Fundus photo; 50° field of view:
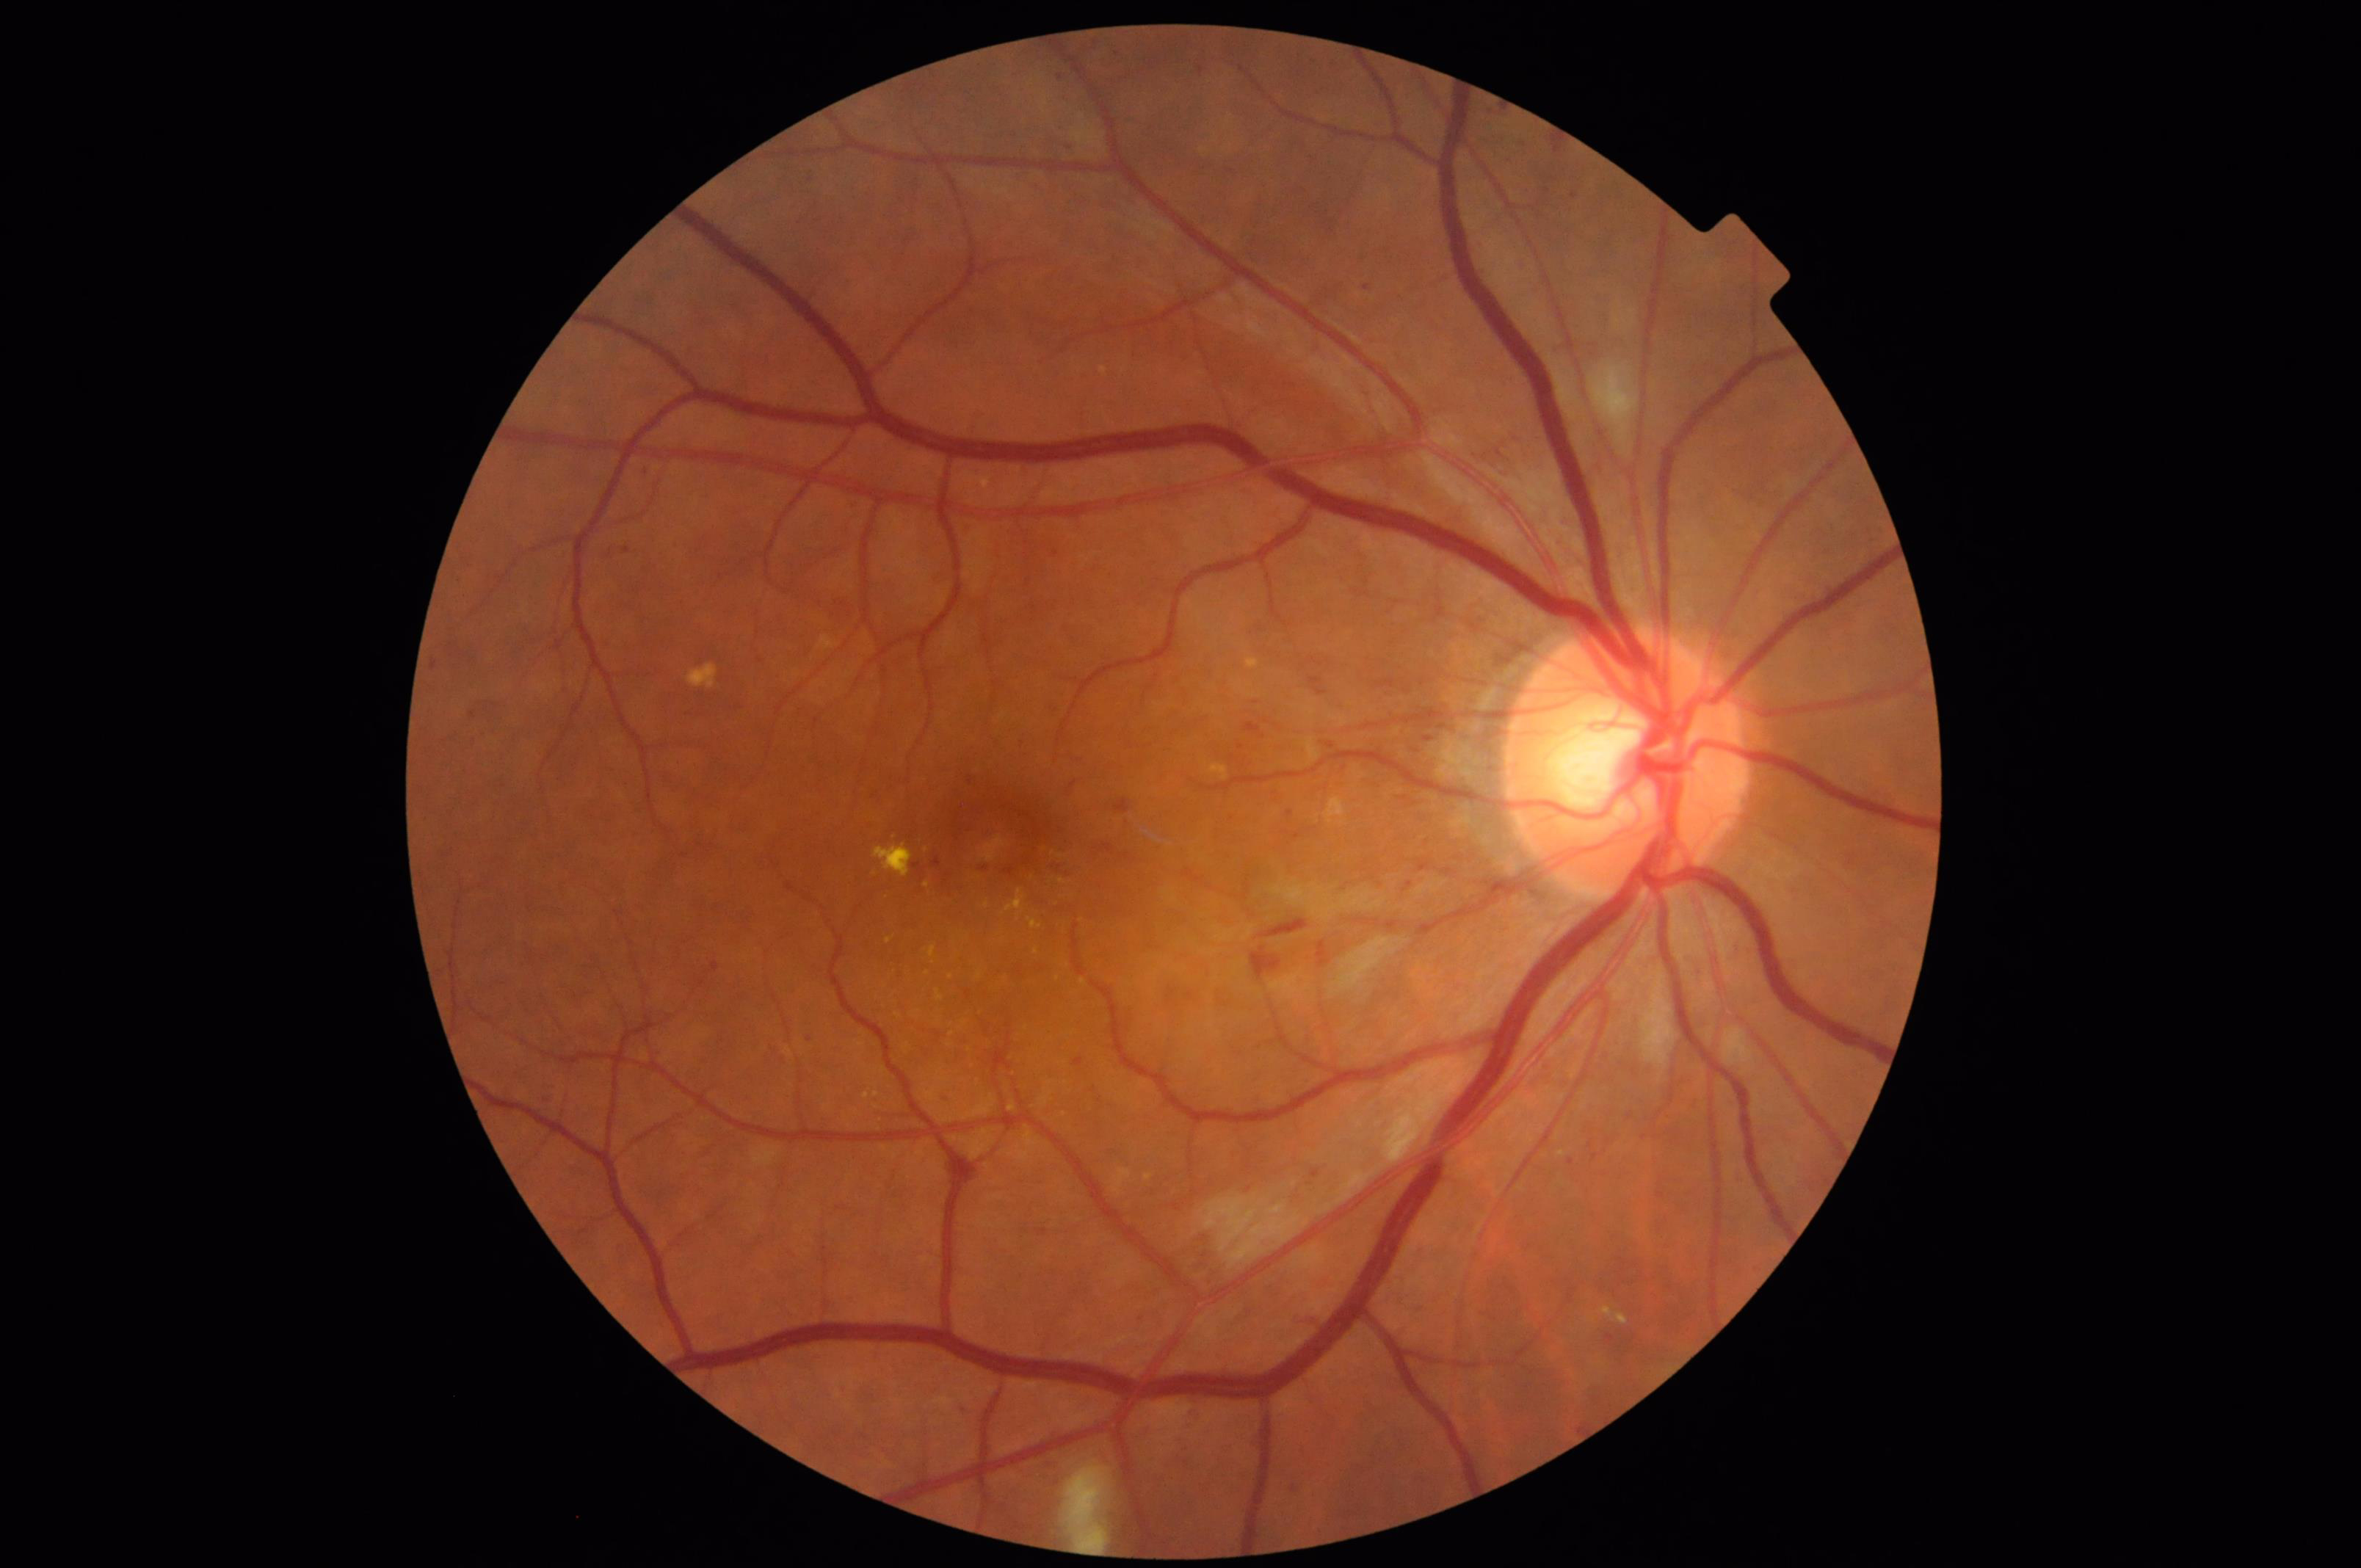 The image is clear.
No over- or under-exposure.